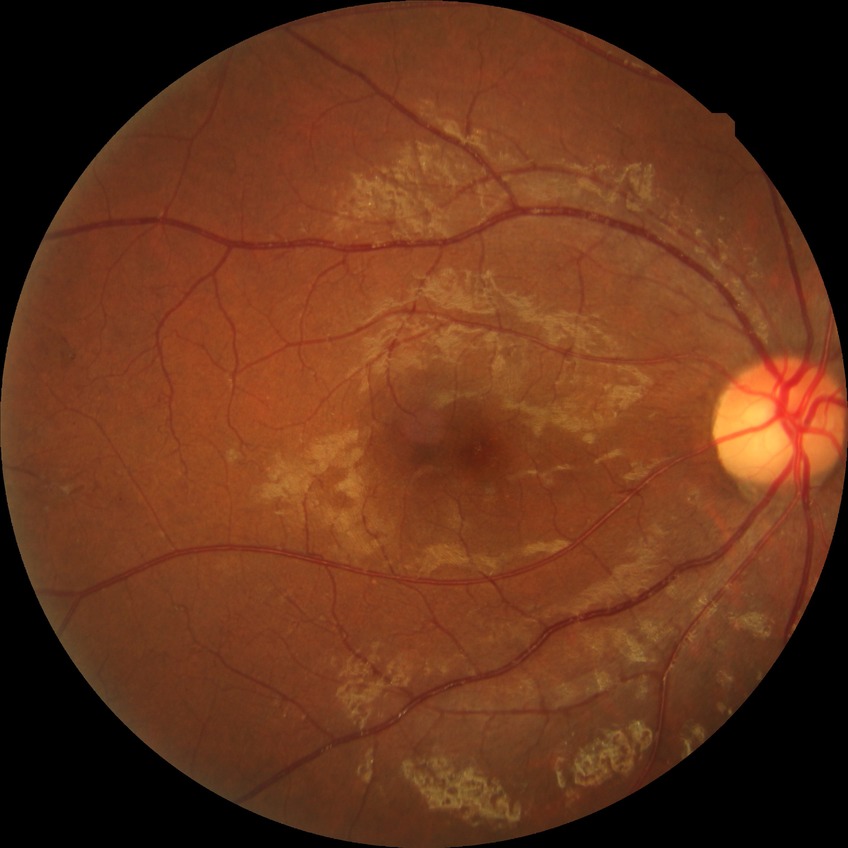

DR@PDR.